50° field of view. Captured on a Topcon TRC-50DX fundus camera
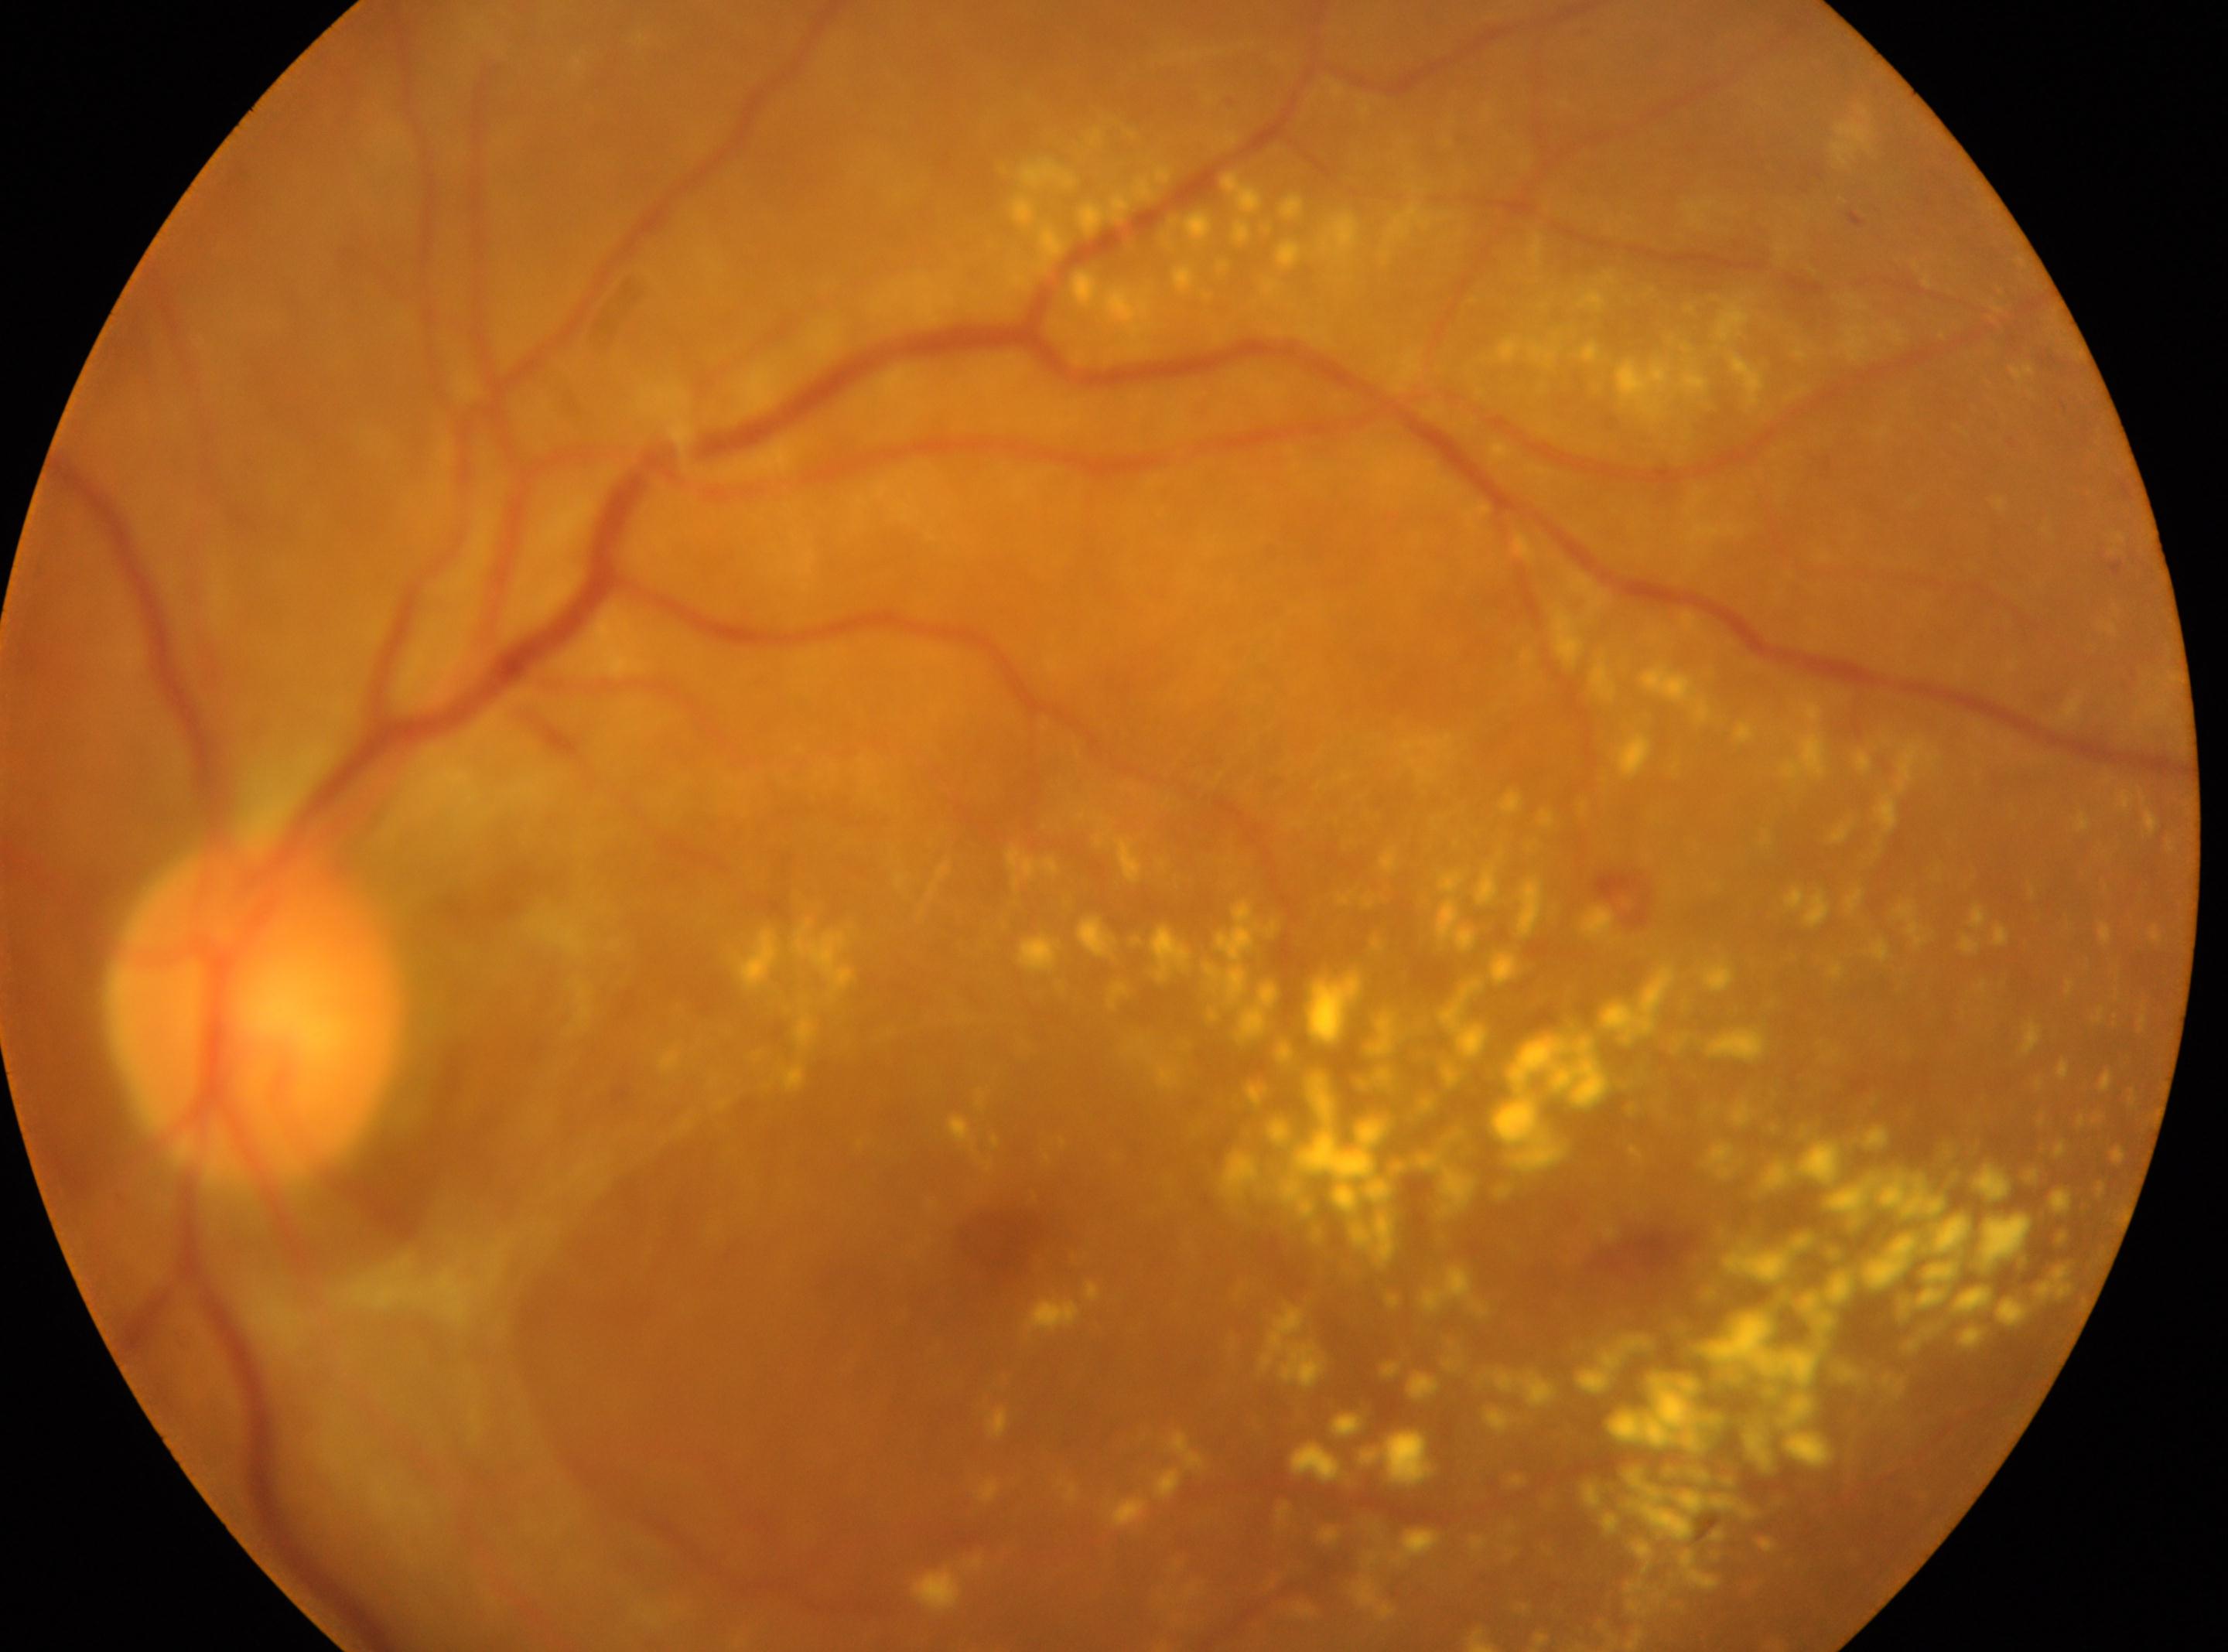 The macular center is at 995, 1231. Optic nerve head: 255, 1011. This is the OS. DR grade: PDR (4).